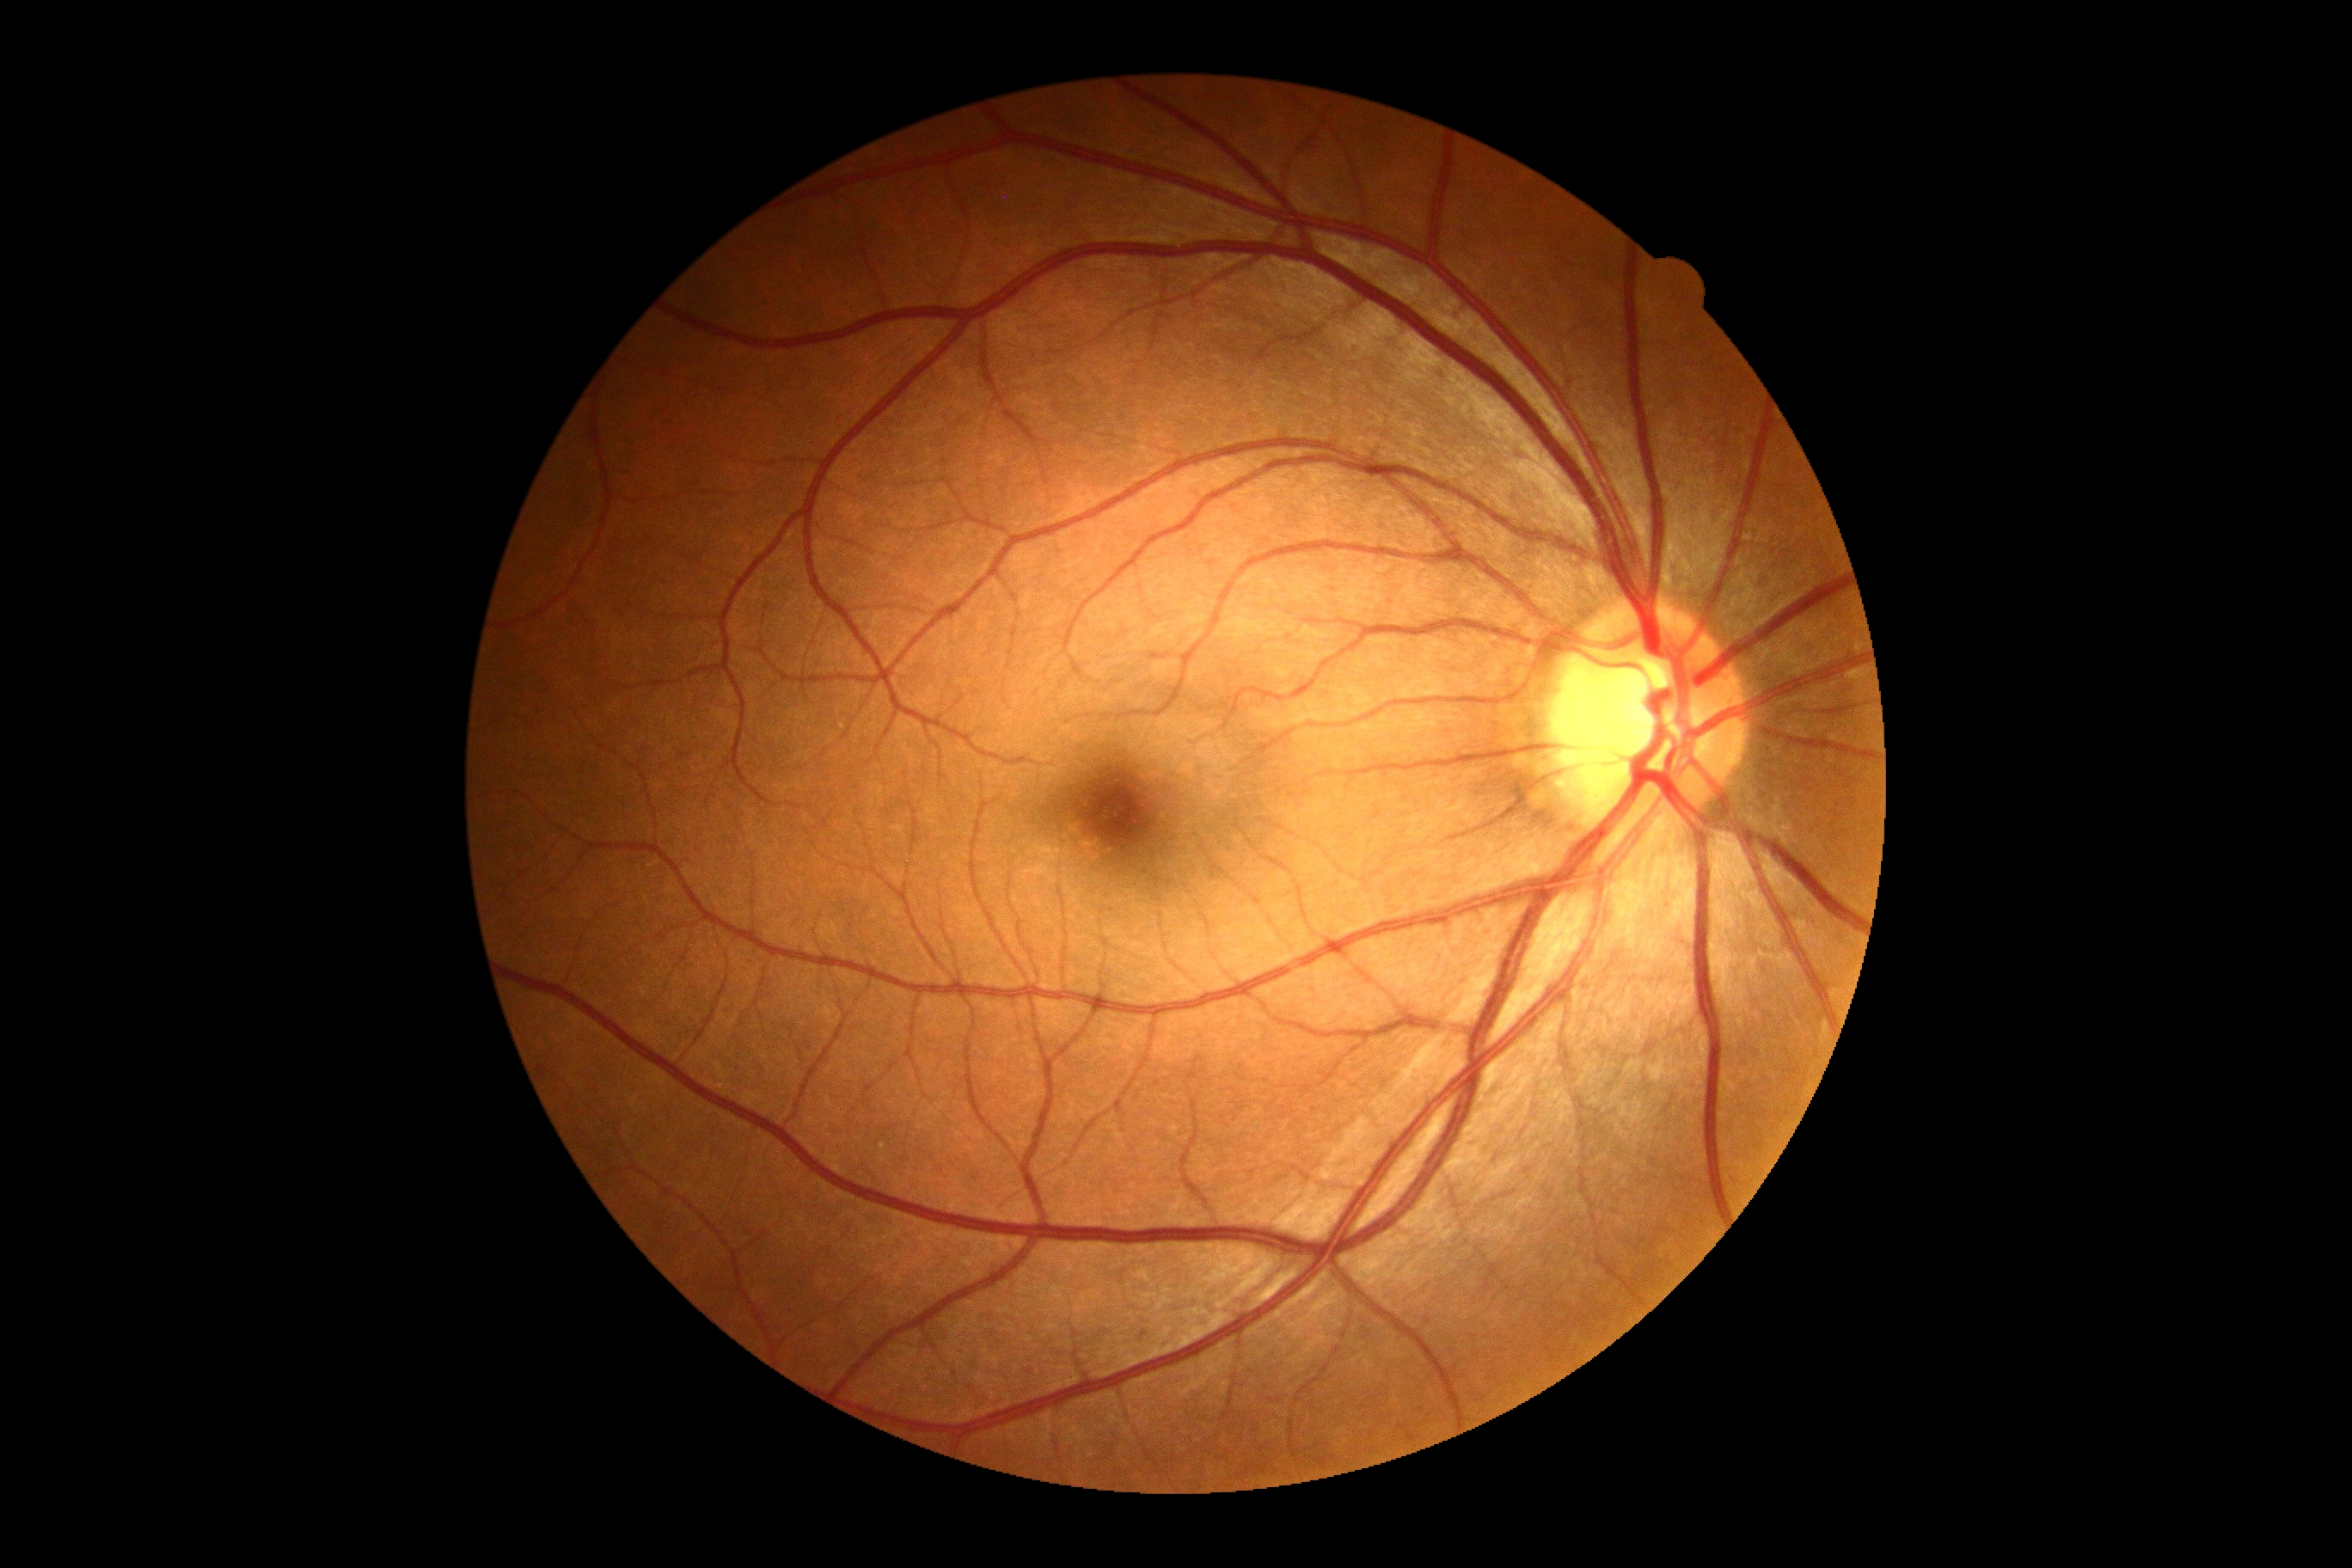

DR impression: no signs of DR, diabetic retinopathy: grade 0 (no apparent retinopathy).